Optic nerve head crop · fundus photo
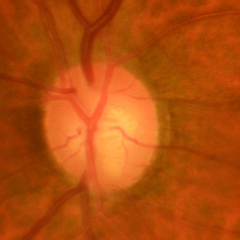
Q: What stage of glaucoma is present?
A: Yes — early glaucomatous optic neuropathy.